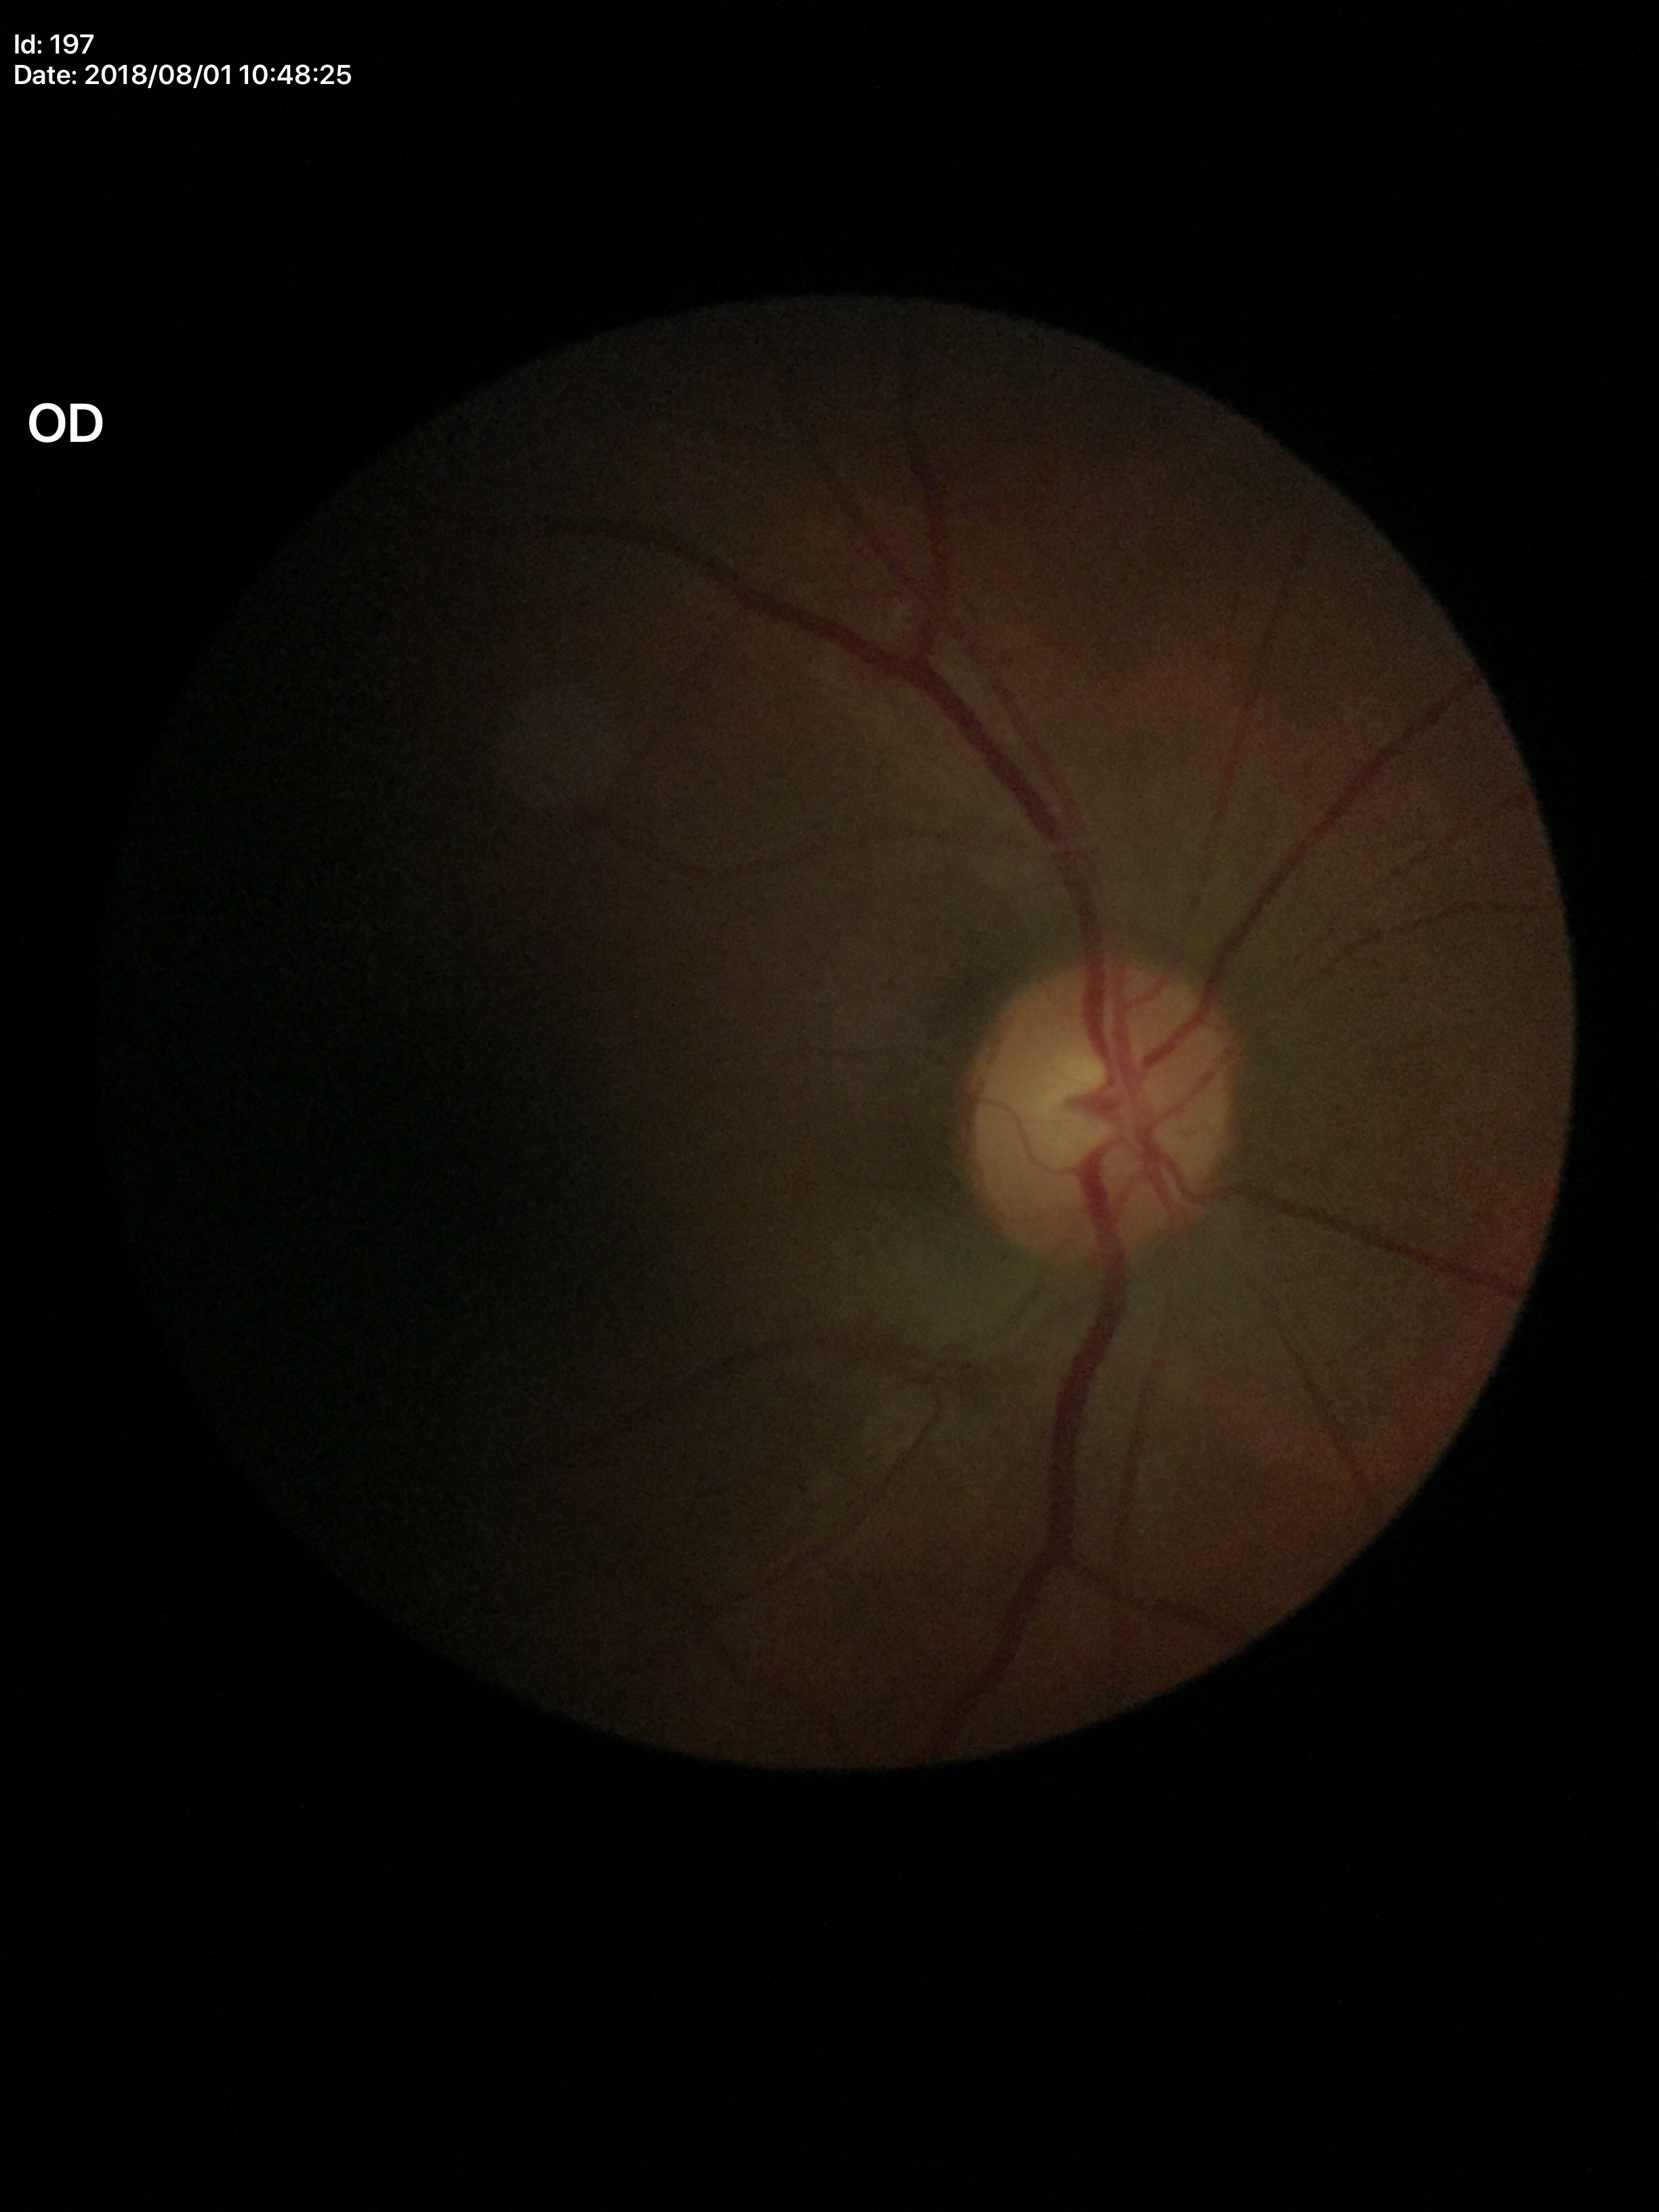 Glaucoma impression: not suspect, ACDR: 0.29, VCDR: 0.51.